45-degree field of view. Nonmydriatic. NIDEK AFC-230 fundus camera:
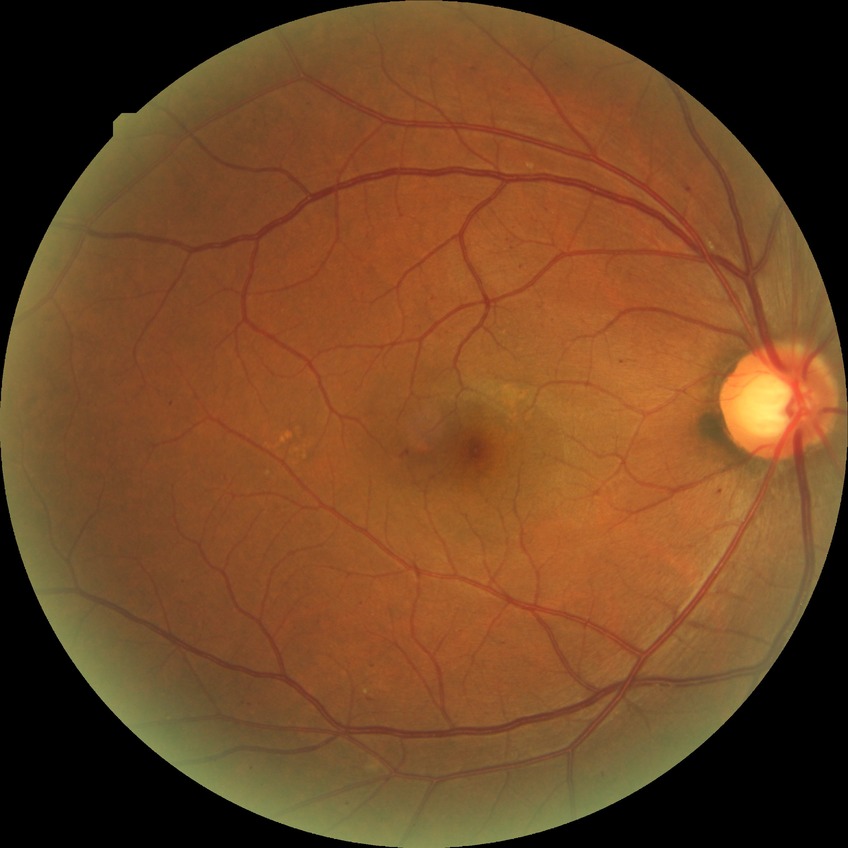
DR class: non-proliferative diabetic retinopathy. DR severity: SDR.